200-degree field of view; ultra-widefield (UWF) fundus image
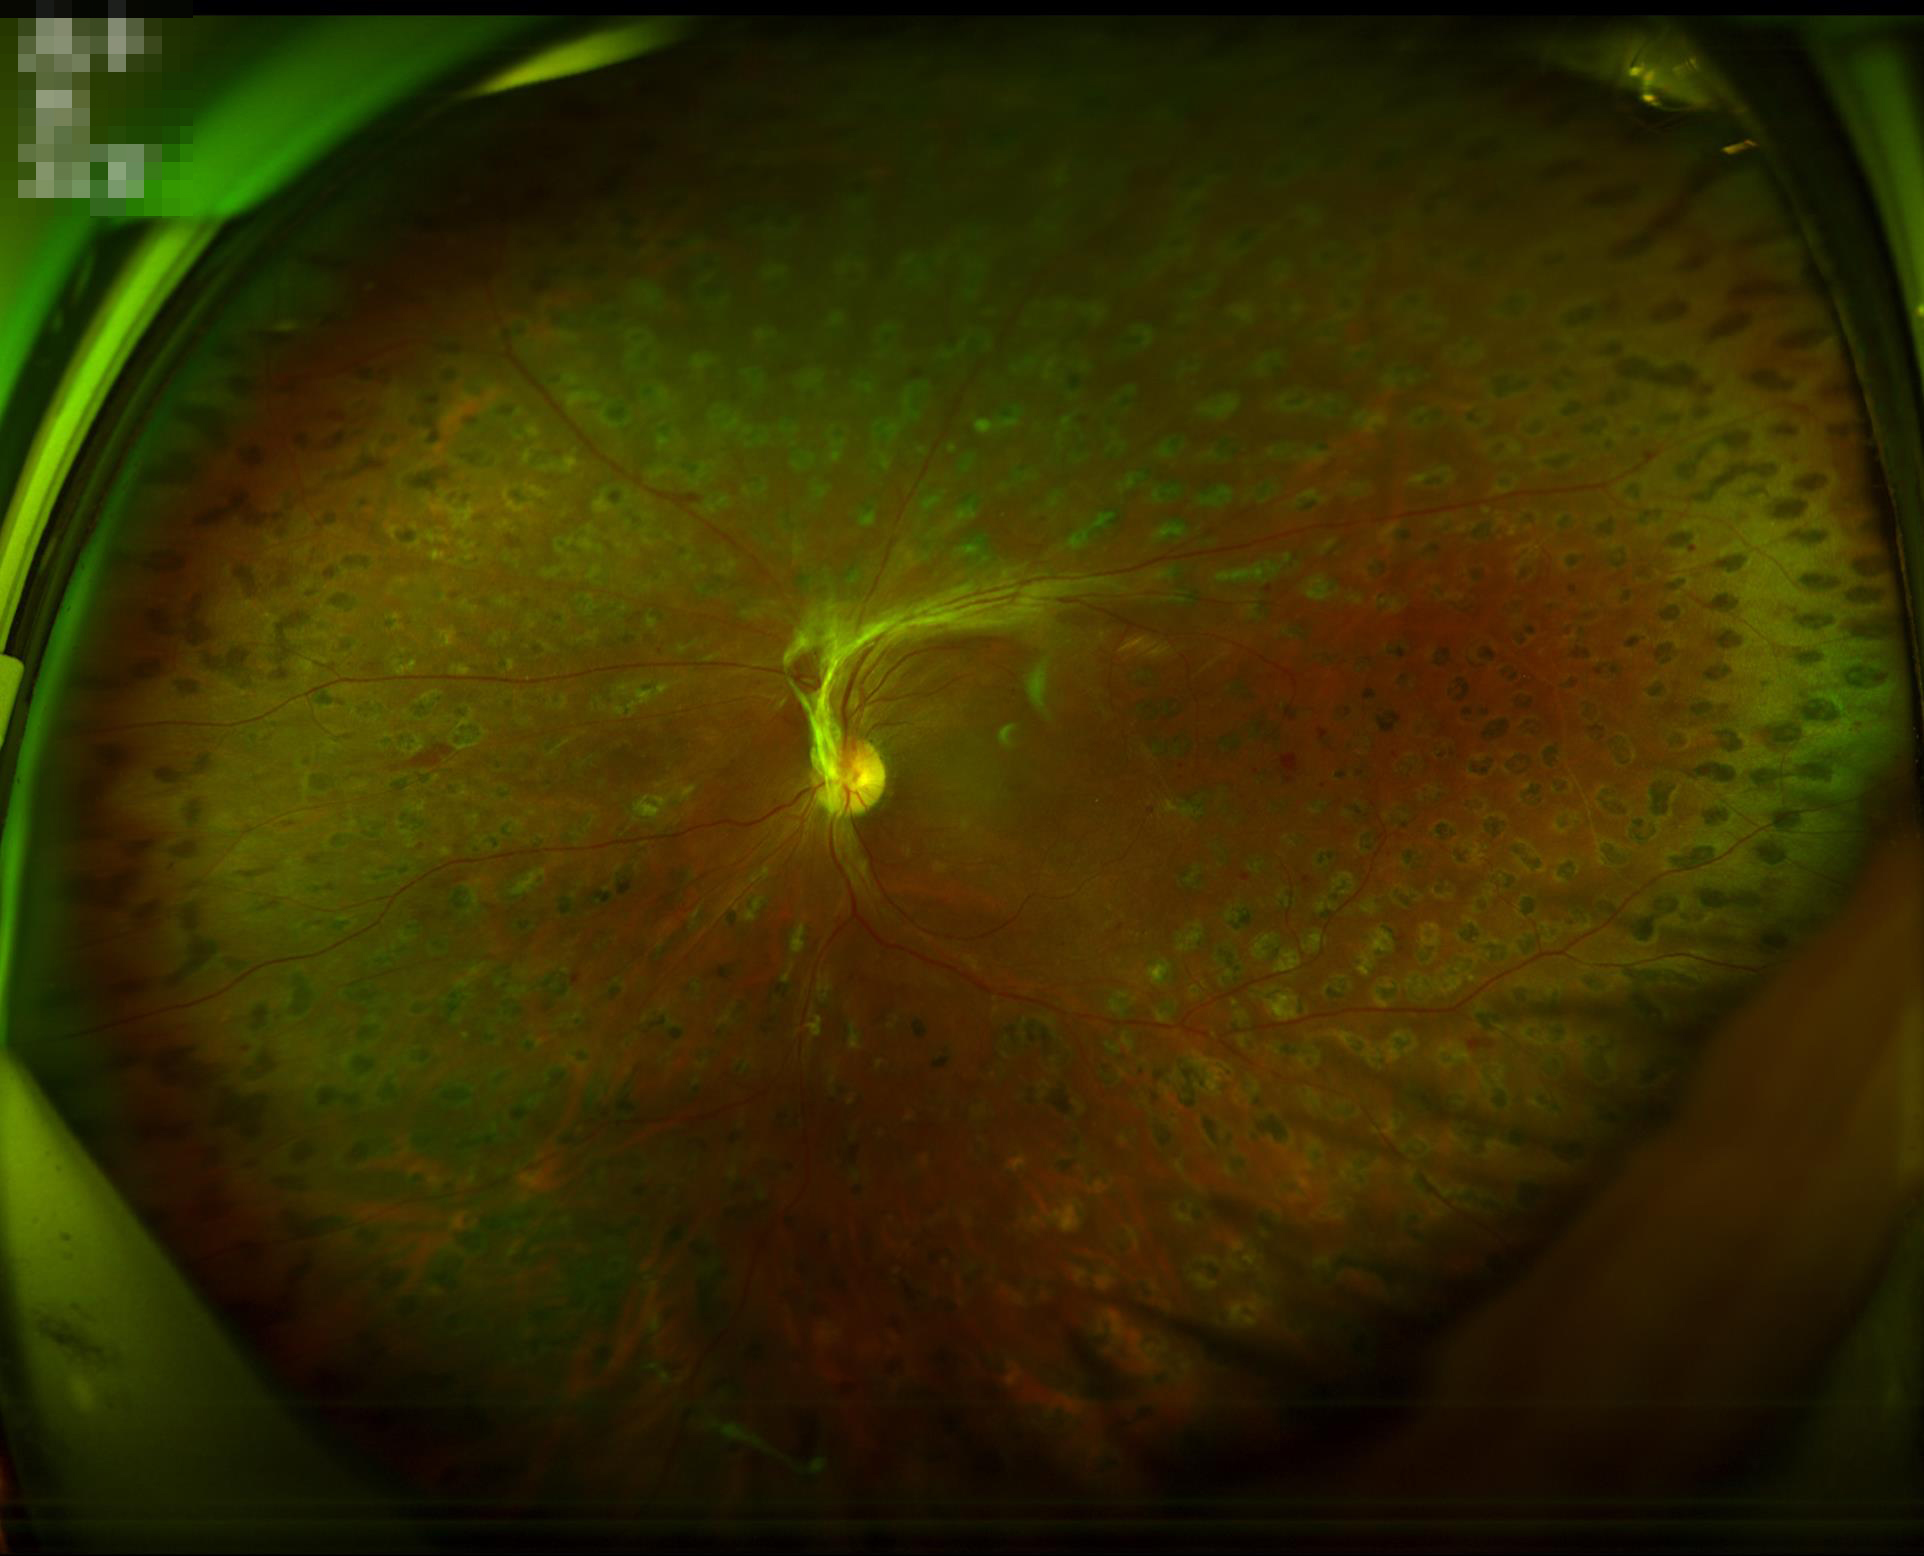 The image is clear.
No over- or under-exposure.
Good dynamic range.
Overall quality is good and the image is gradable.